Pediatric wide-field fundus photograph · 1240x1240 · 100° field of view (Phoenix ICON)
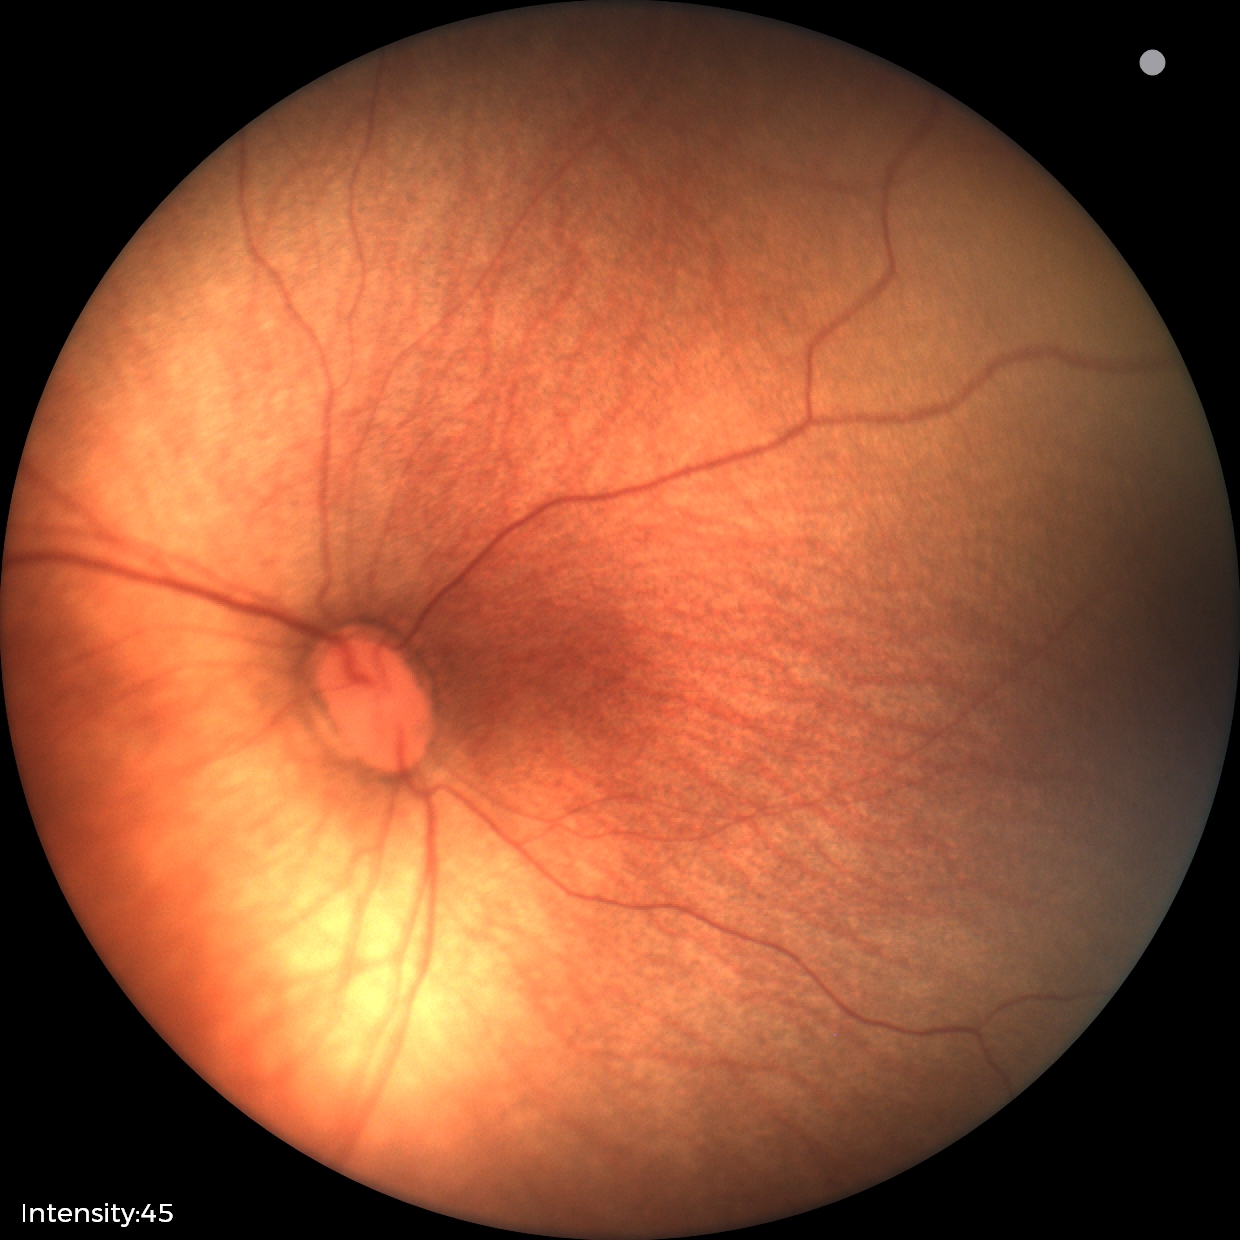 Diagnosis from this screening exam: ROP stage 1.
Without plus disease.